1932 x 1932 pixels, camera: Topcon TRC-NW8:
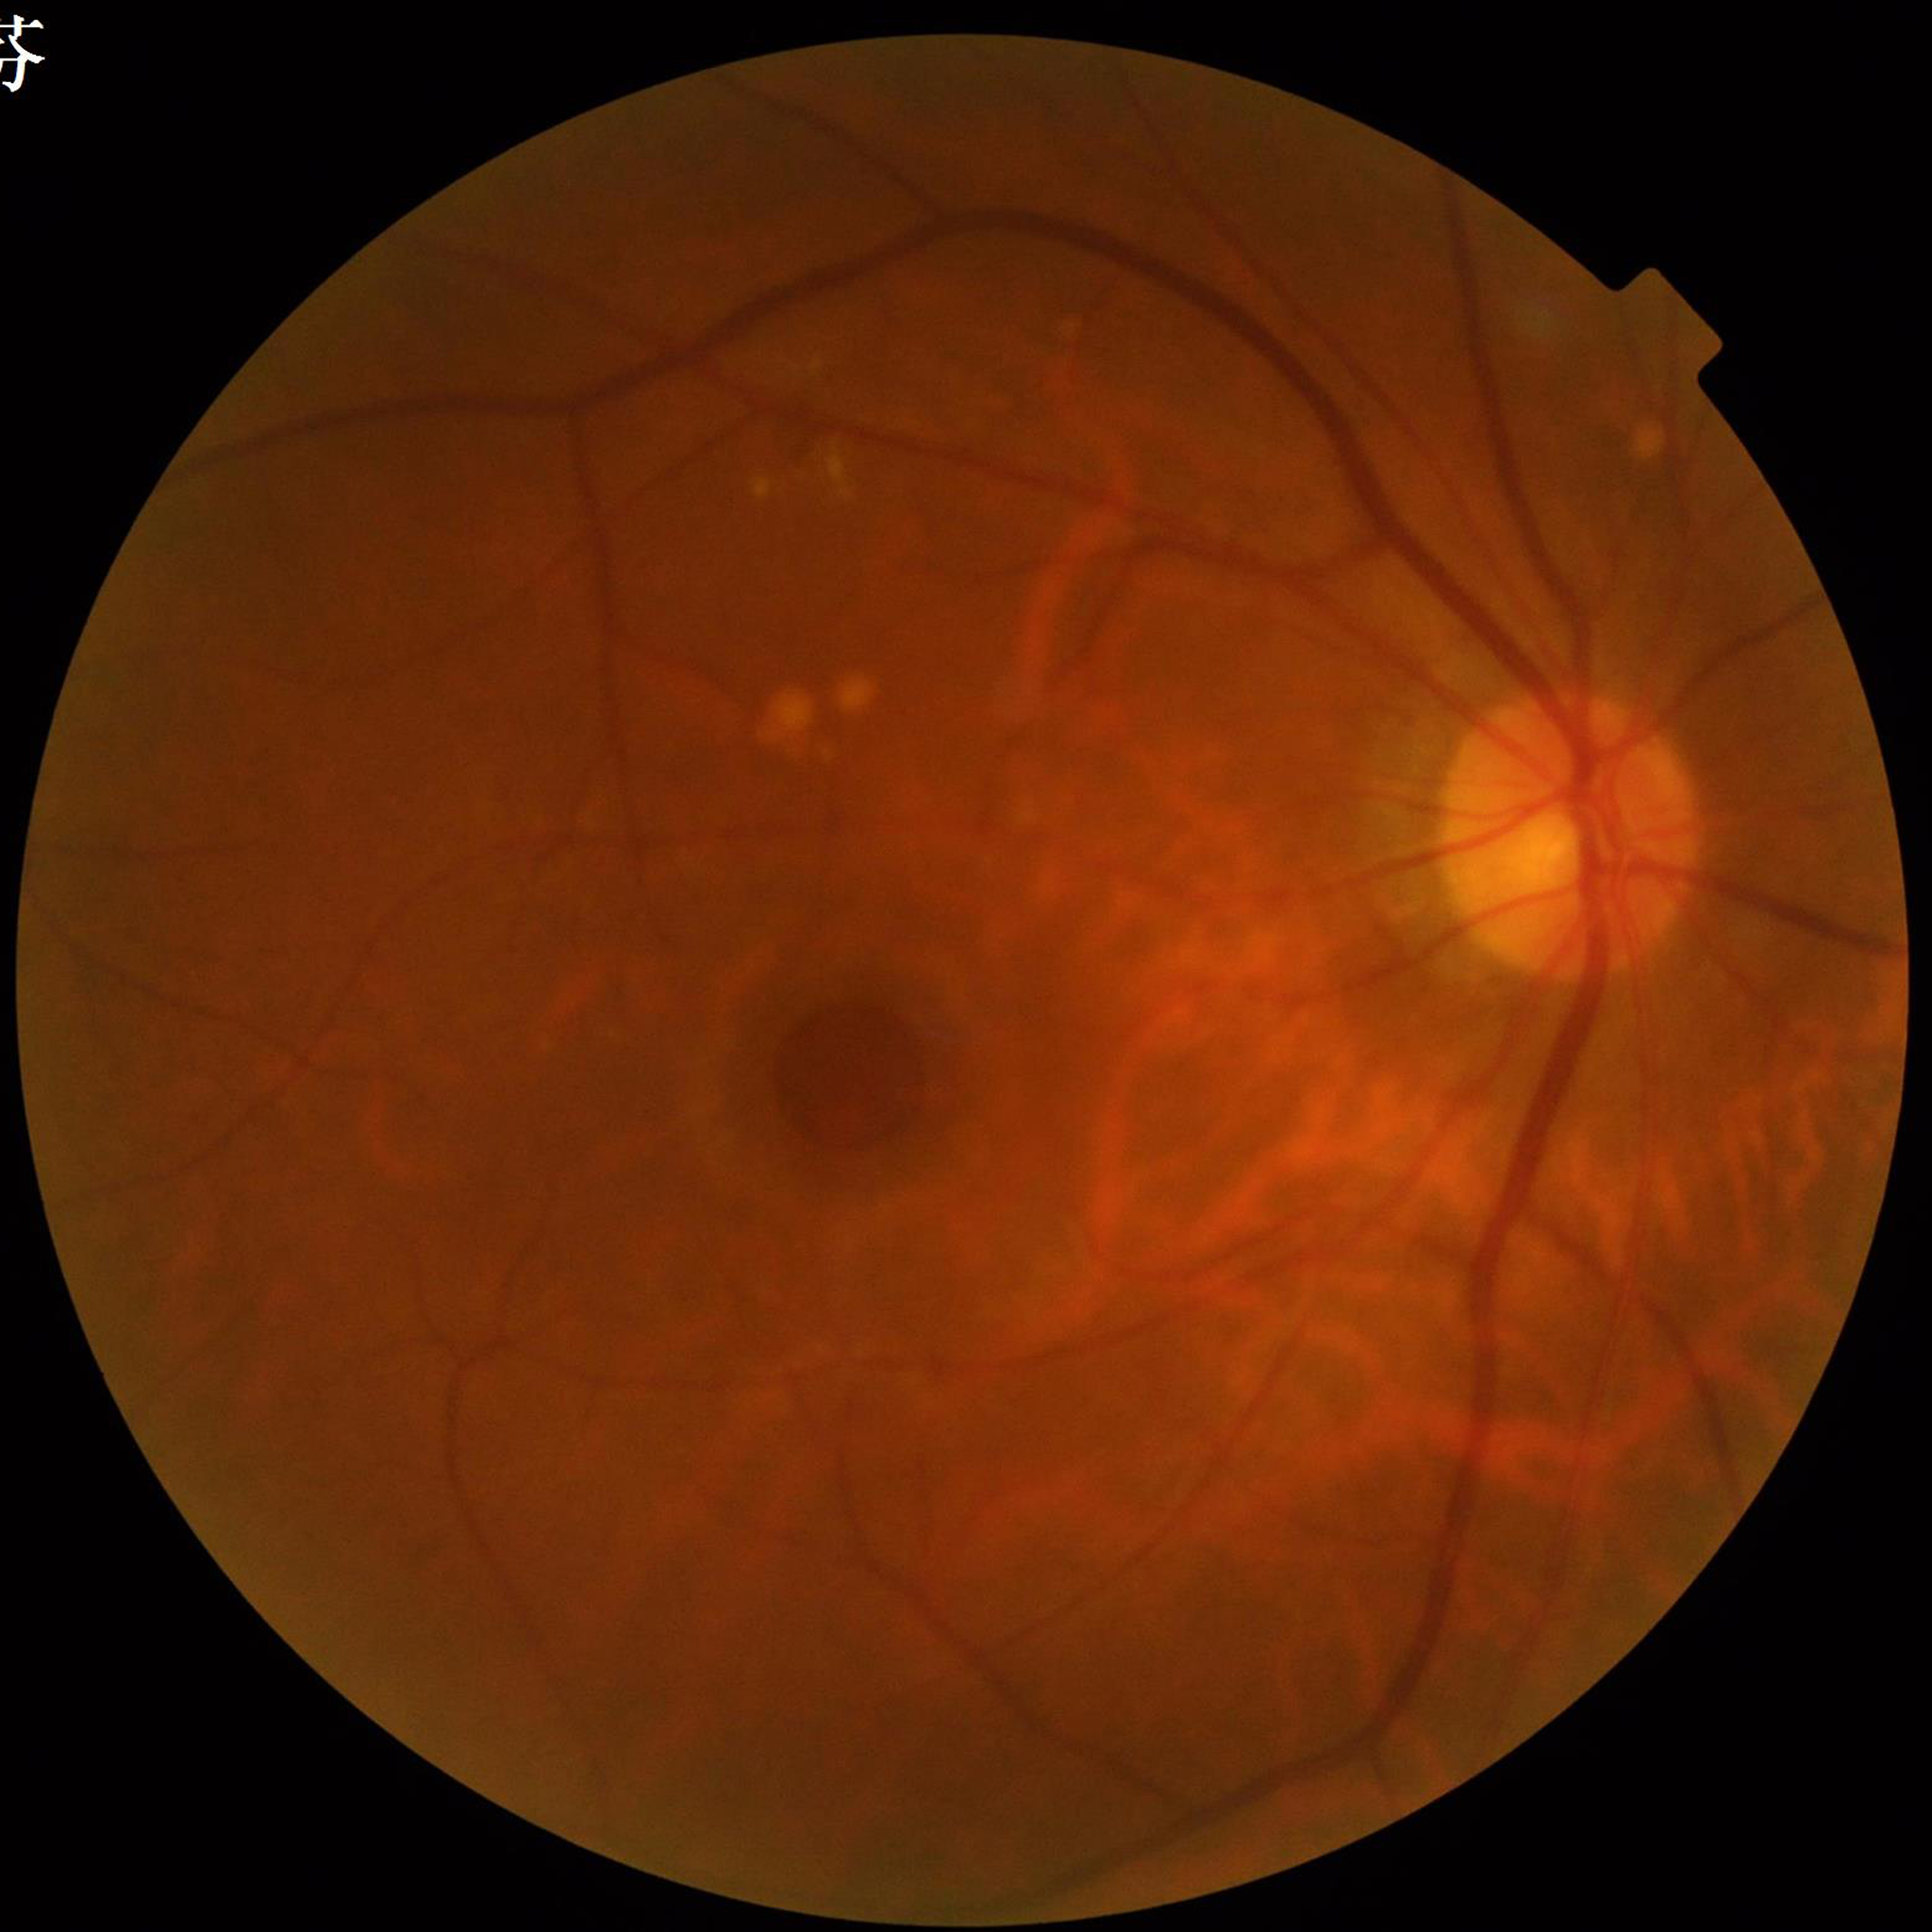 Diagnosis: diabetic retinopathy (DR)
Automated quality assessment: poor — blur